Color fundus image
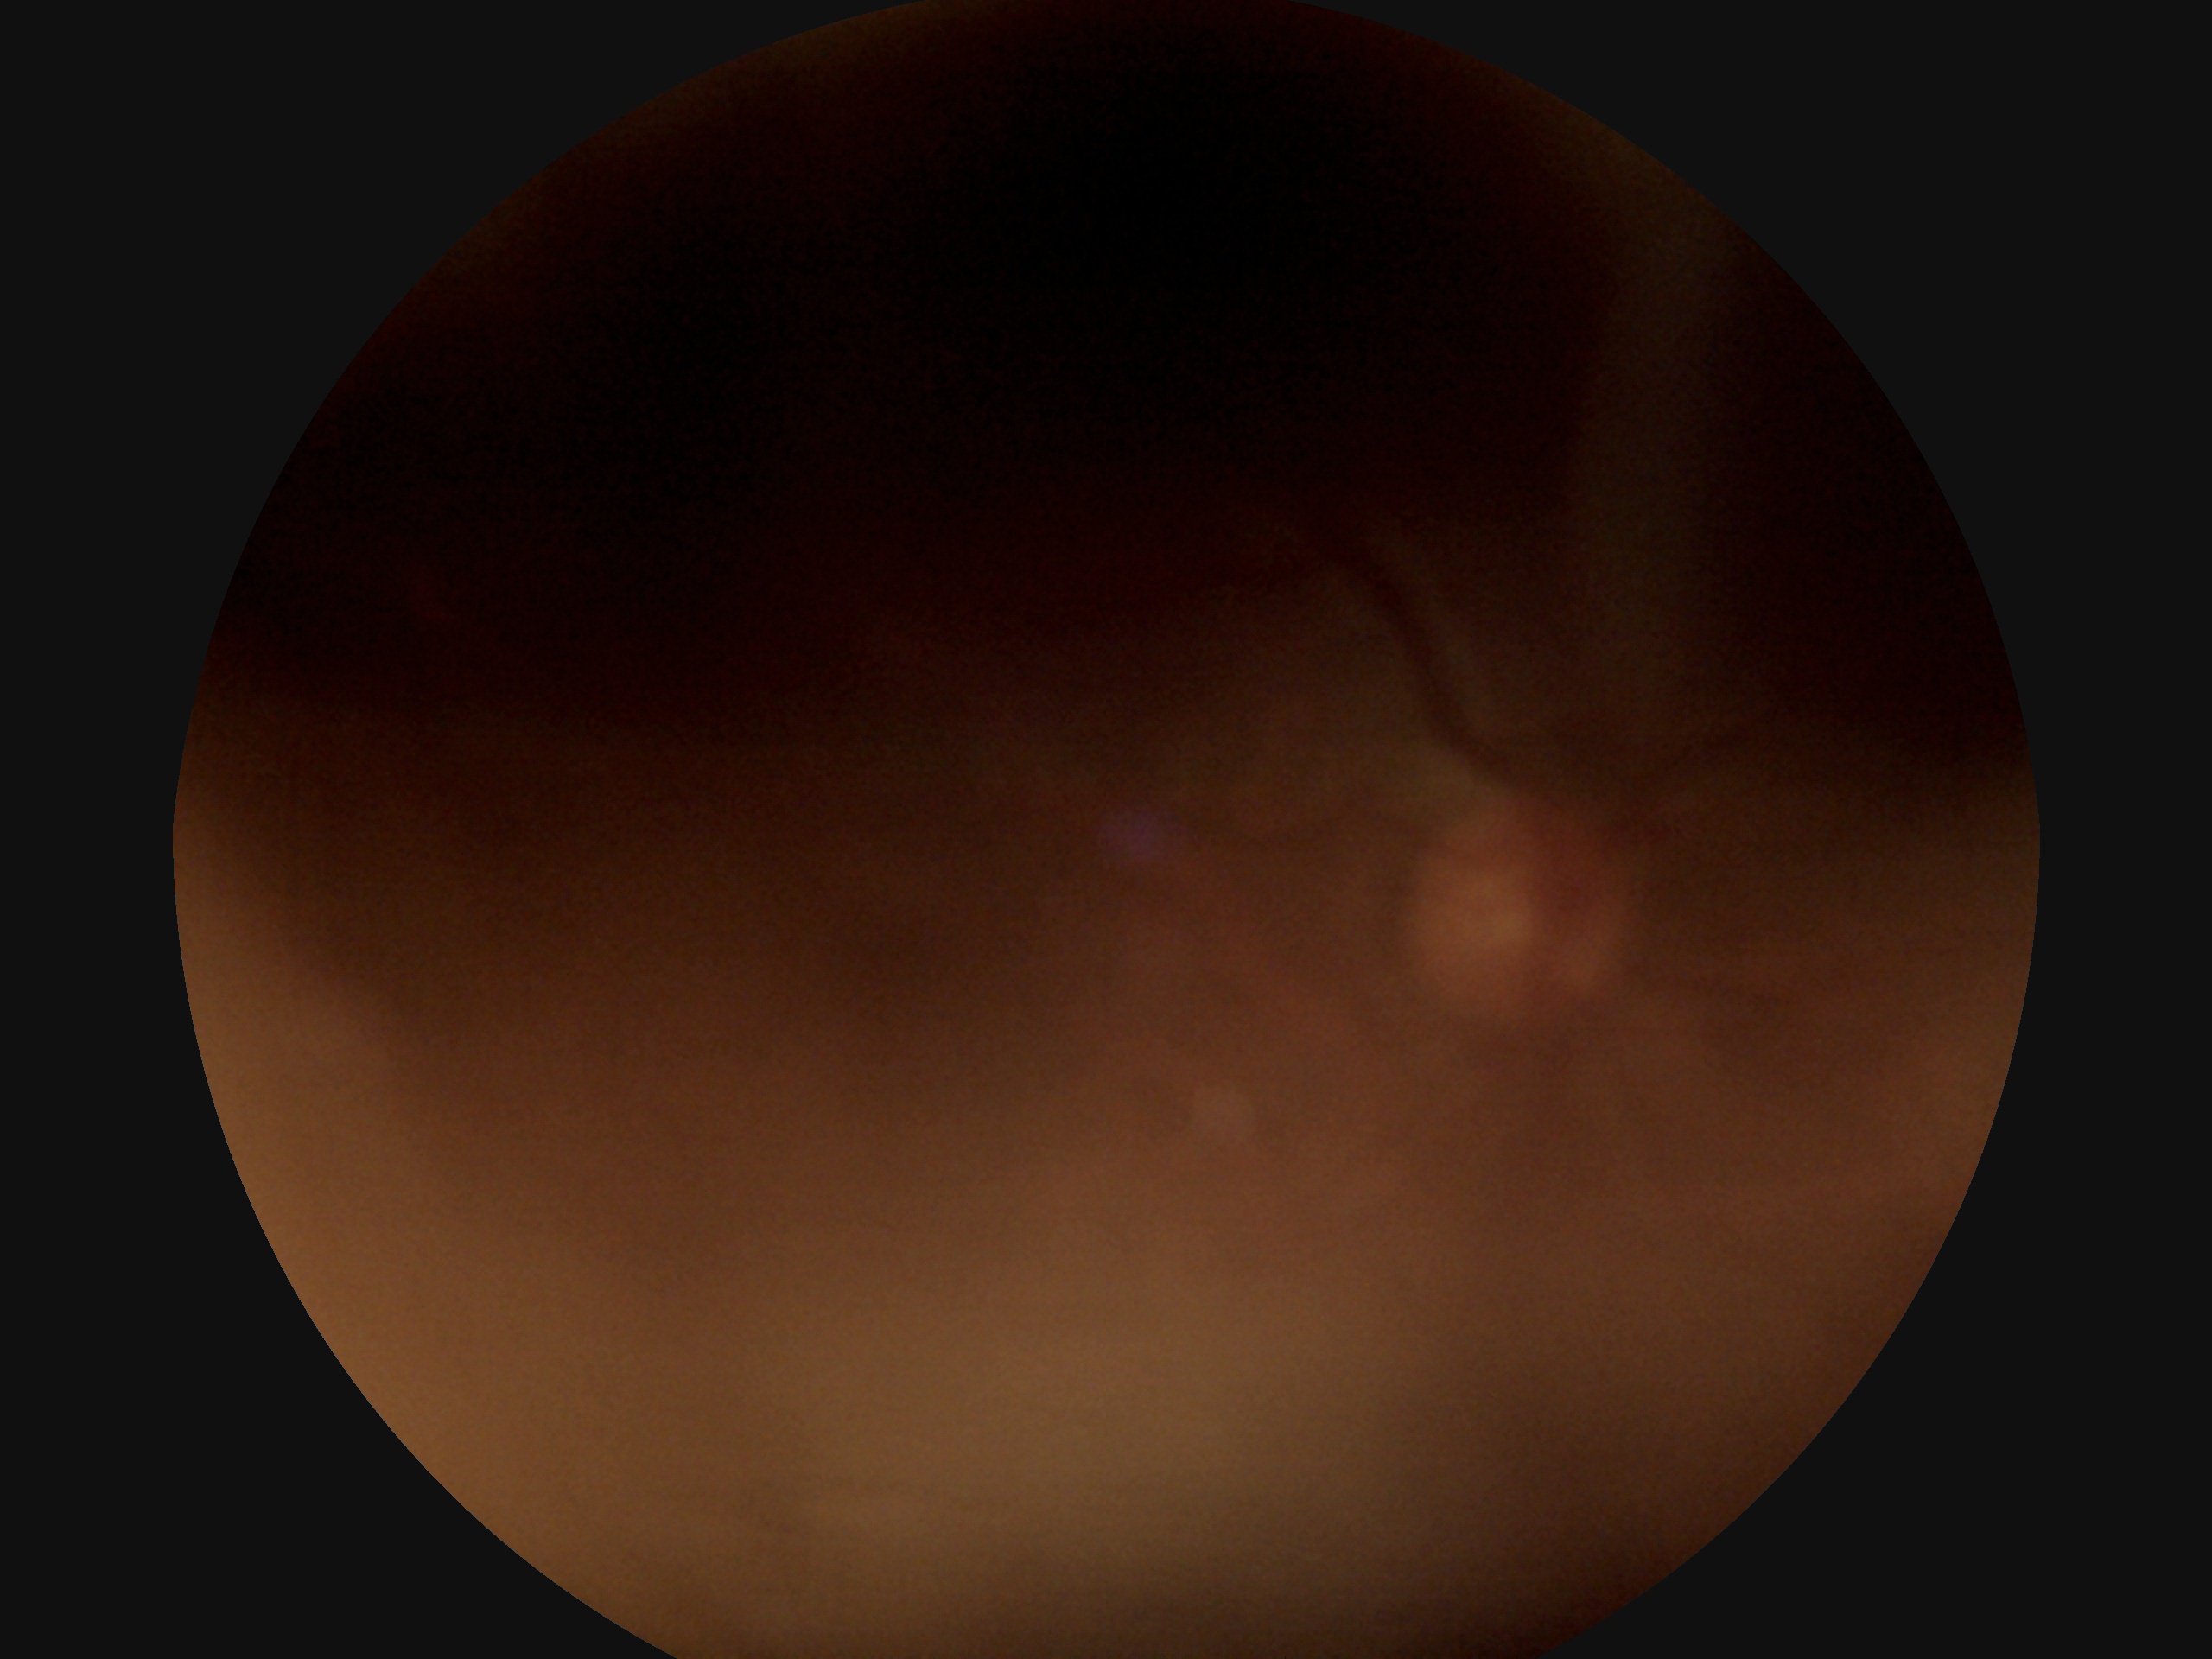 Image quality is insufficient for diabetic retinopathy assessment.
DR stage: ungradable.